CFP. Image size 2228x1652. Posterior pole field covering the optic disc and macula:
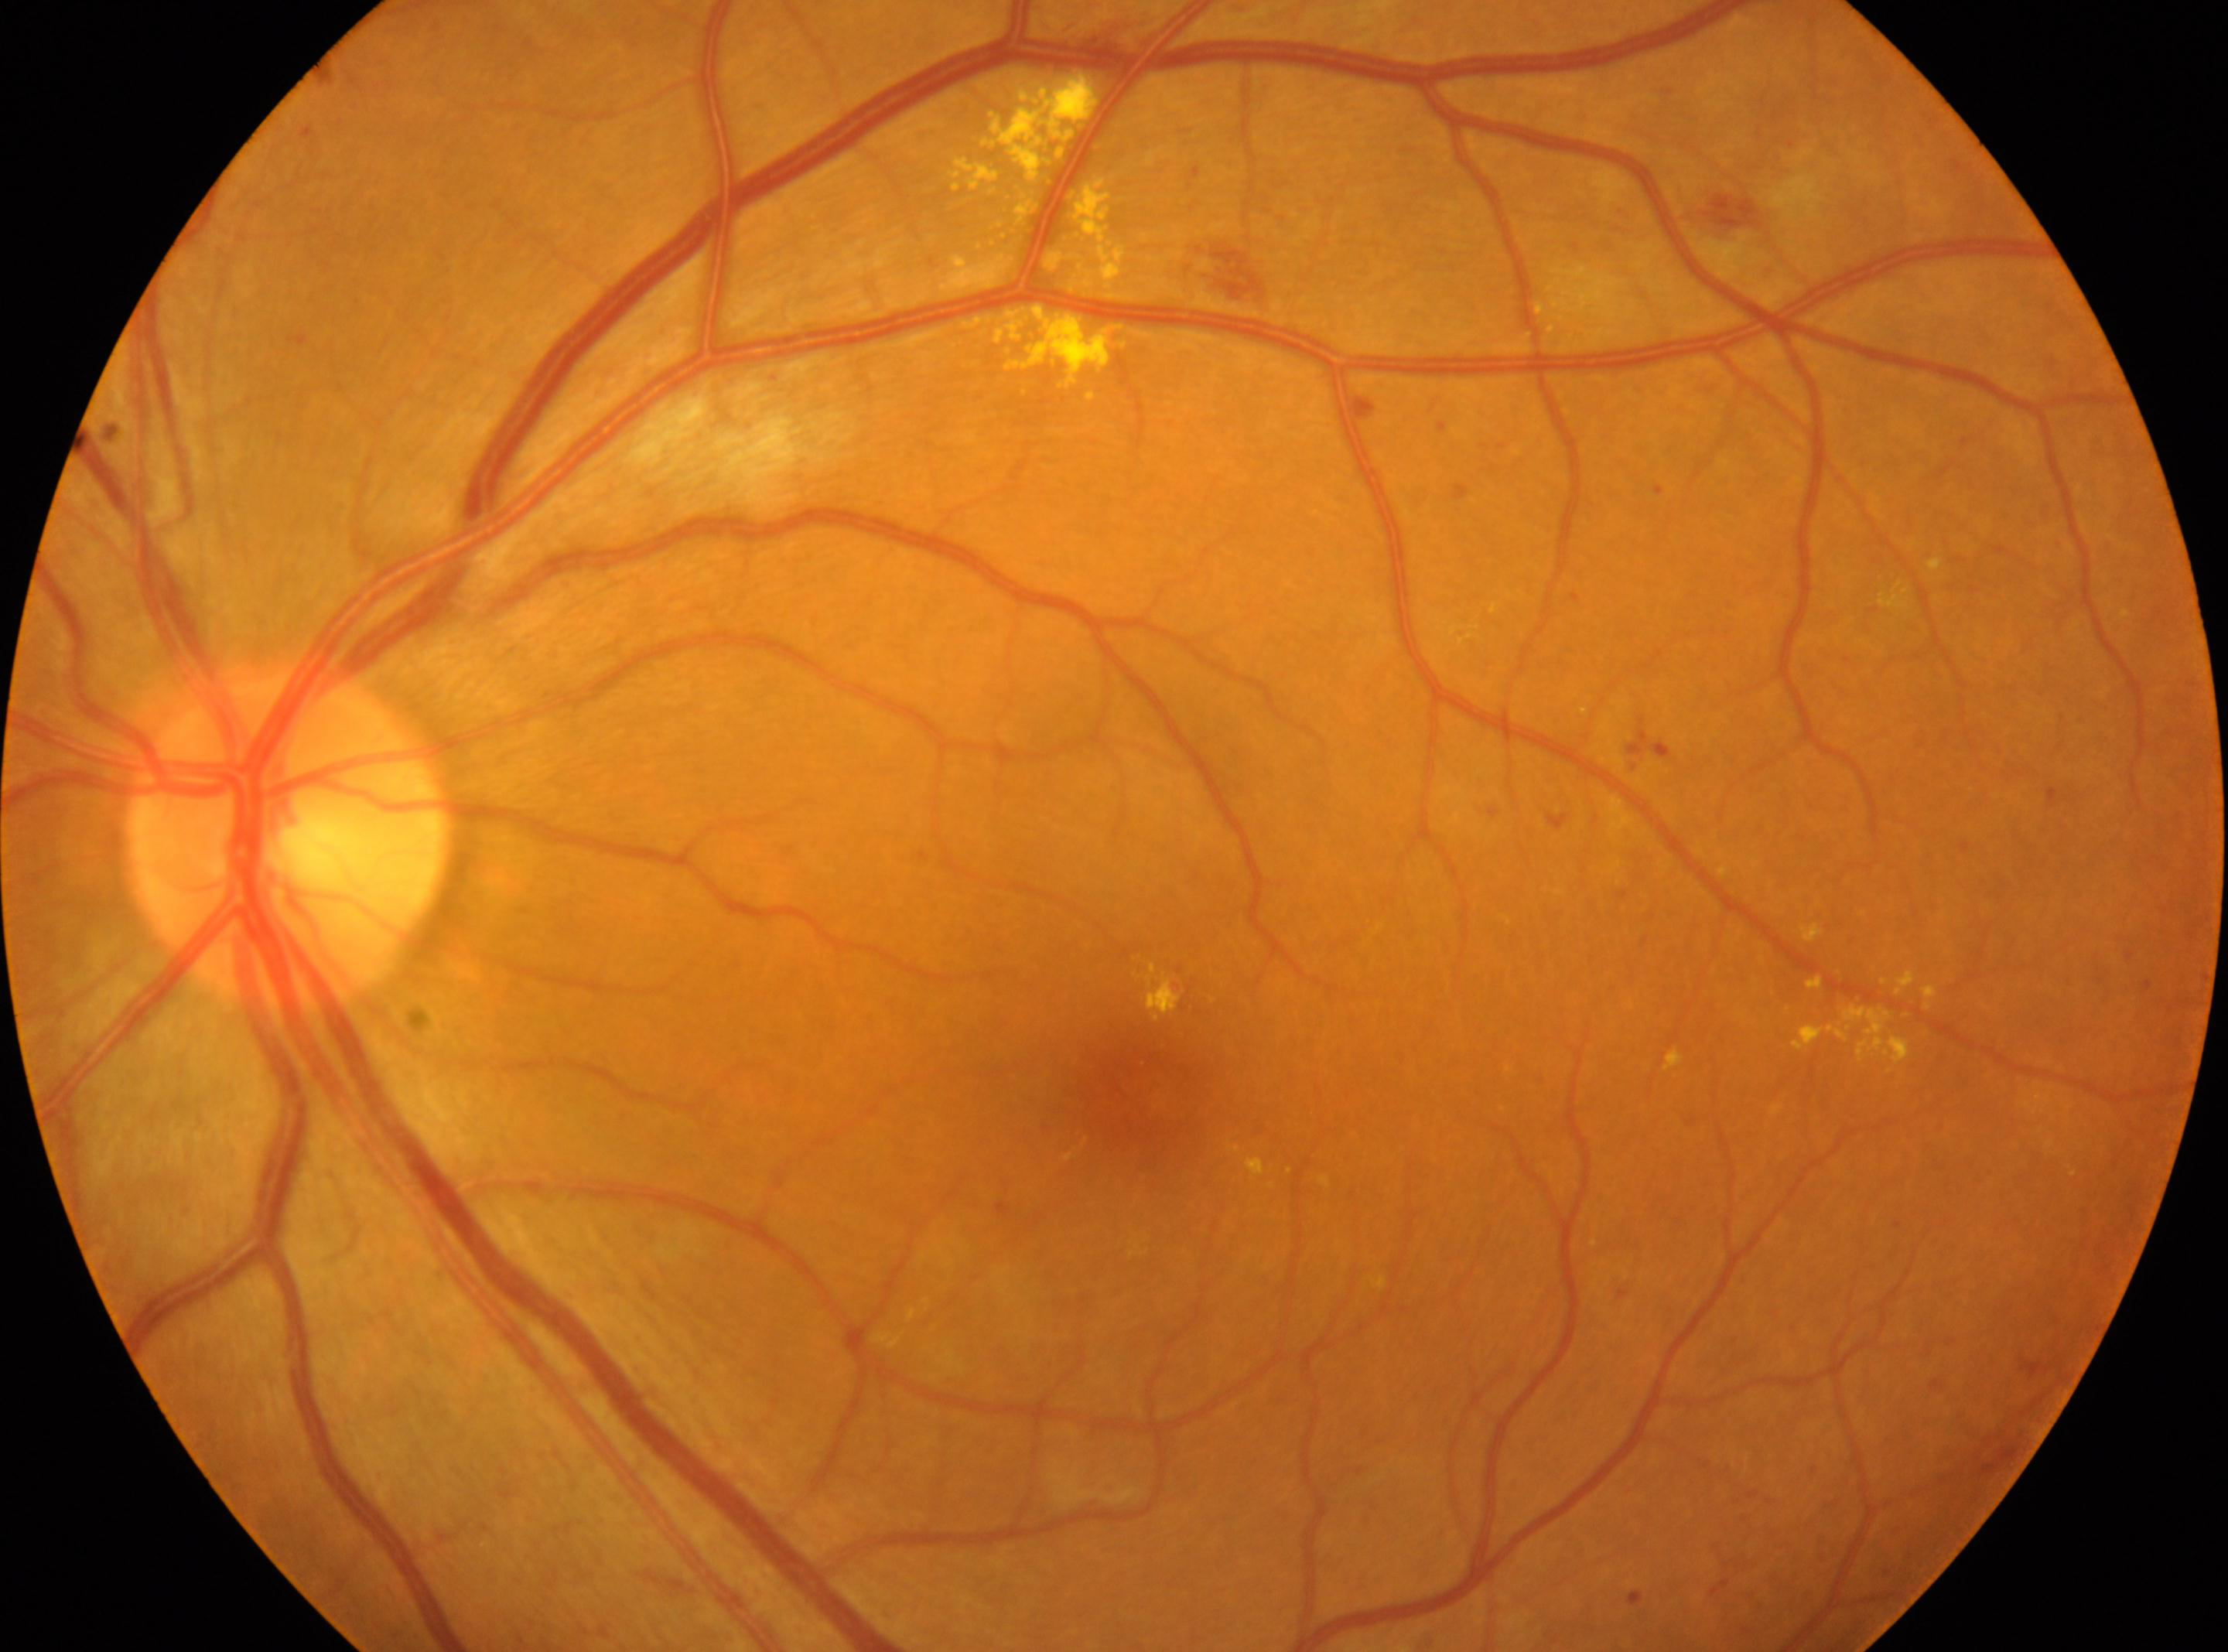

optic nerve head: (288, 838); fovea centralis: (1133, 1112); laterality: oculus sinister; DR grade: moderate NPDR (2); DR class: non-proliferative diabetic retinopathy.